Captured with the Phoenix ICON (100° field of view); image size 1240x1240; wide-field fundus image from infant ROP screening: 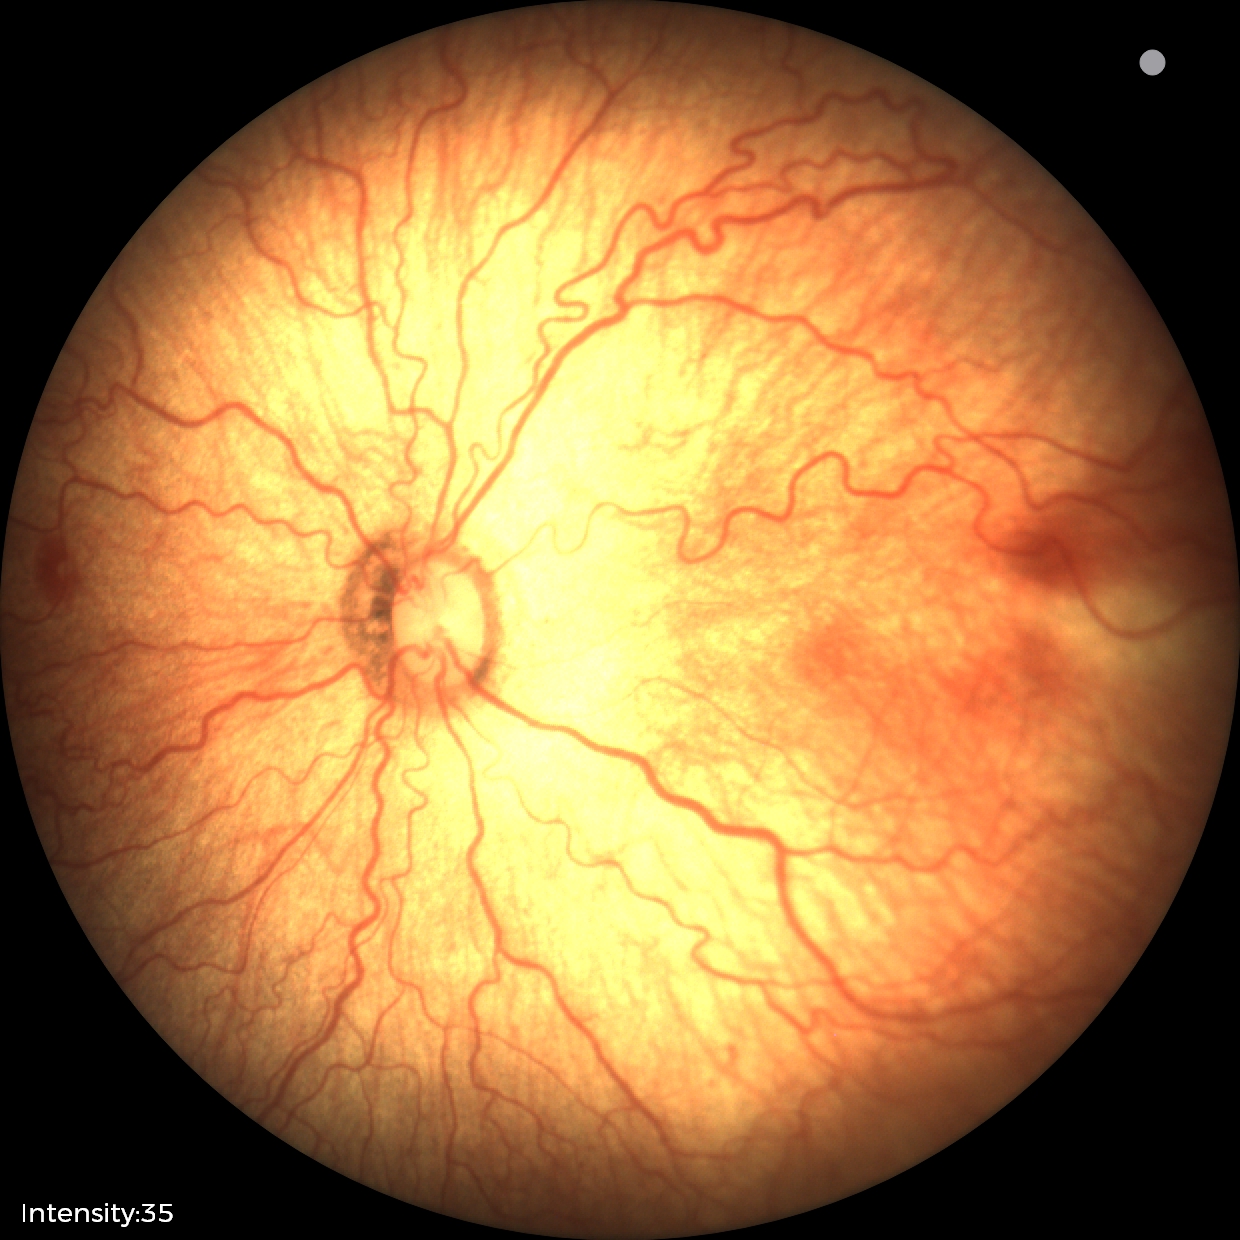

From an examination with diagnosis of retinopathy of prematurity stage 2.